Acquired on the Phoenix ICON; Phoenix ICON wide-field infant fundus image; 1240x1240
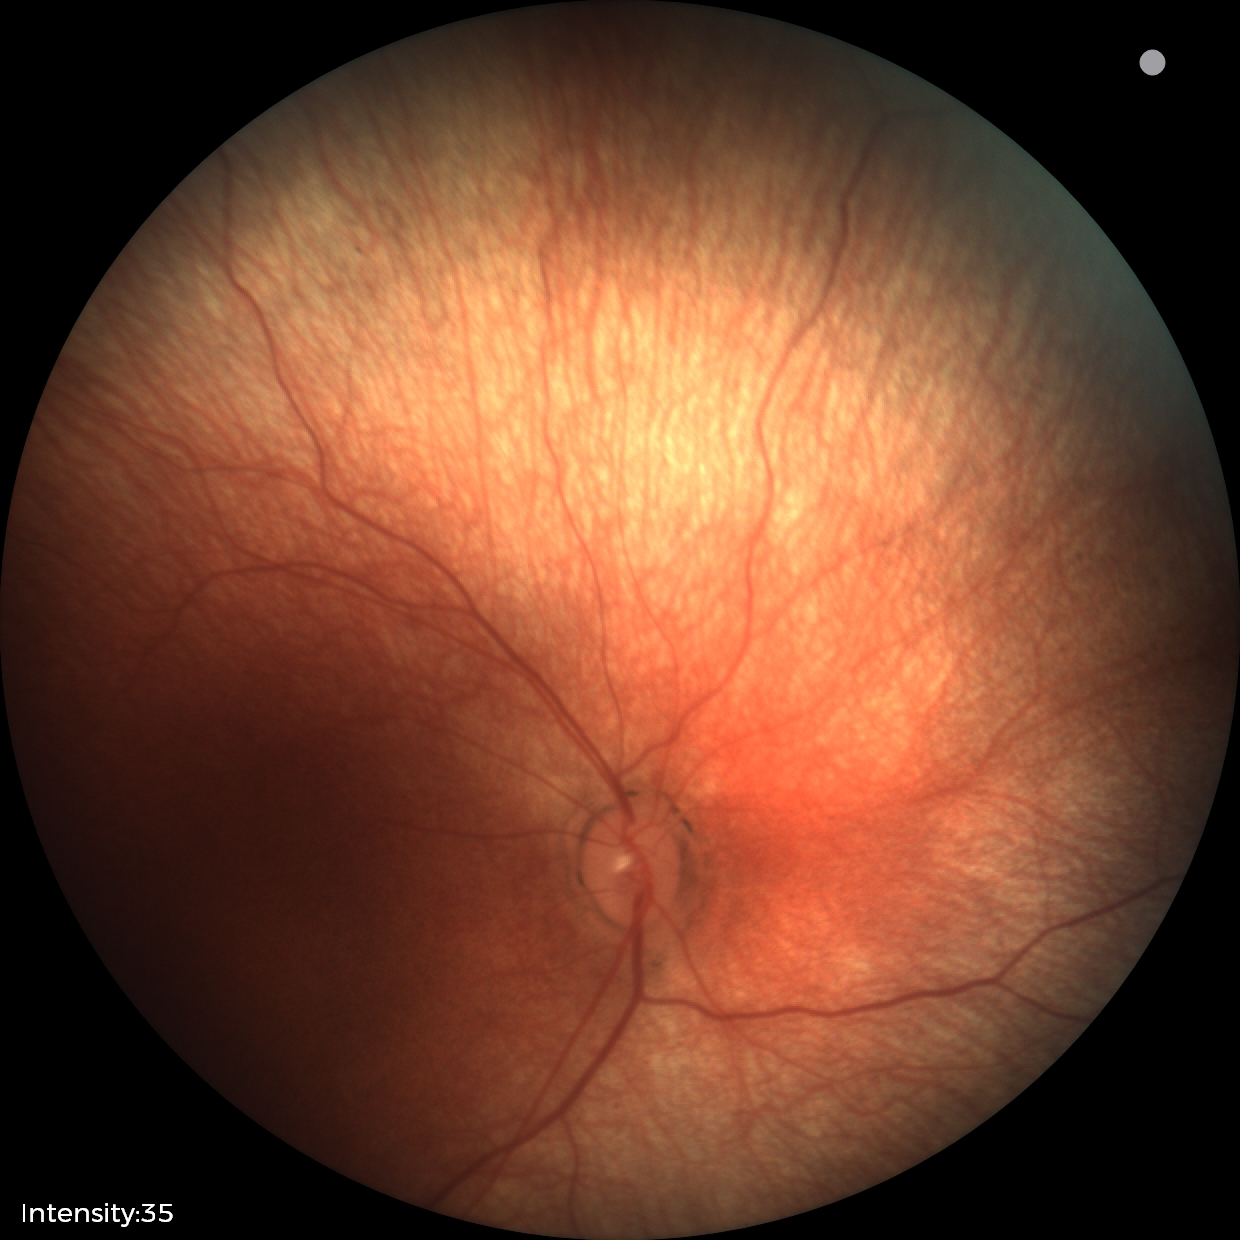 No retinal pathology identified on screening.